Cropped to the optic nerve head:
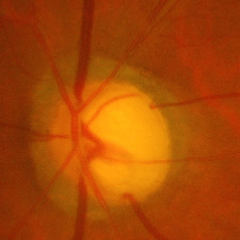
Showing severe glaucomatous damage.